Graded on the modified Davis scale
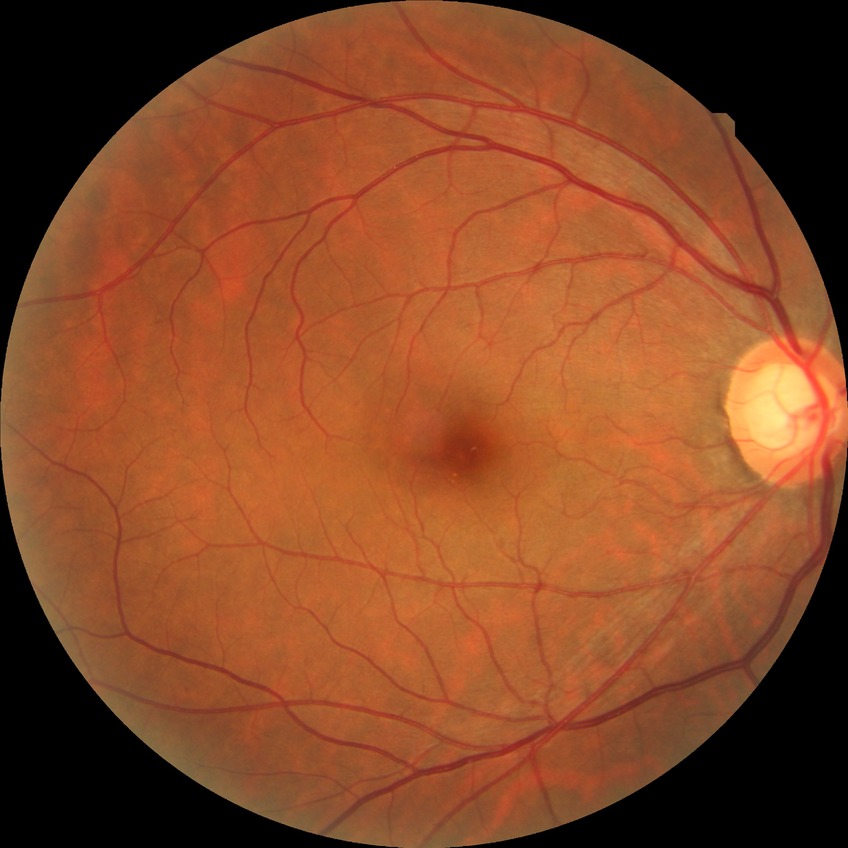
{"davis_grade": "no diabetic retinopathy (NDR)"}